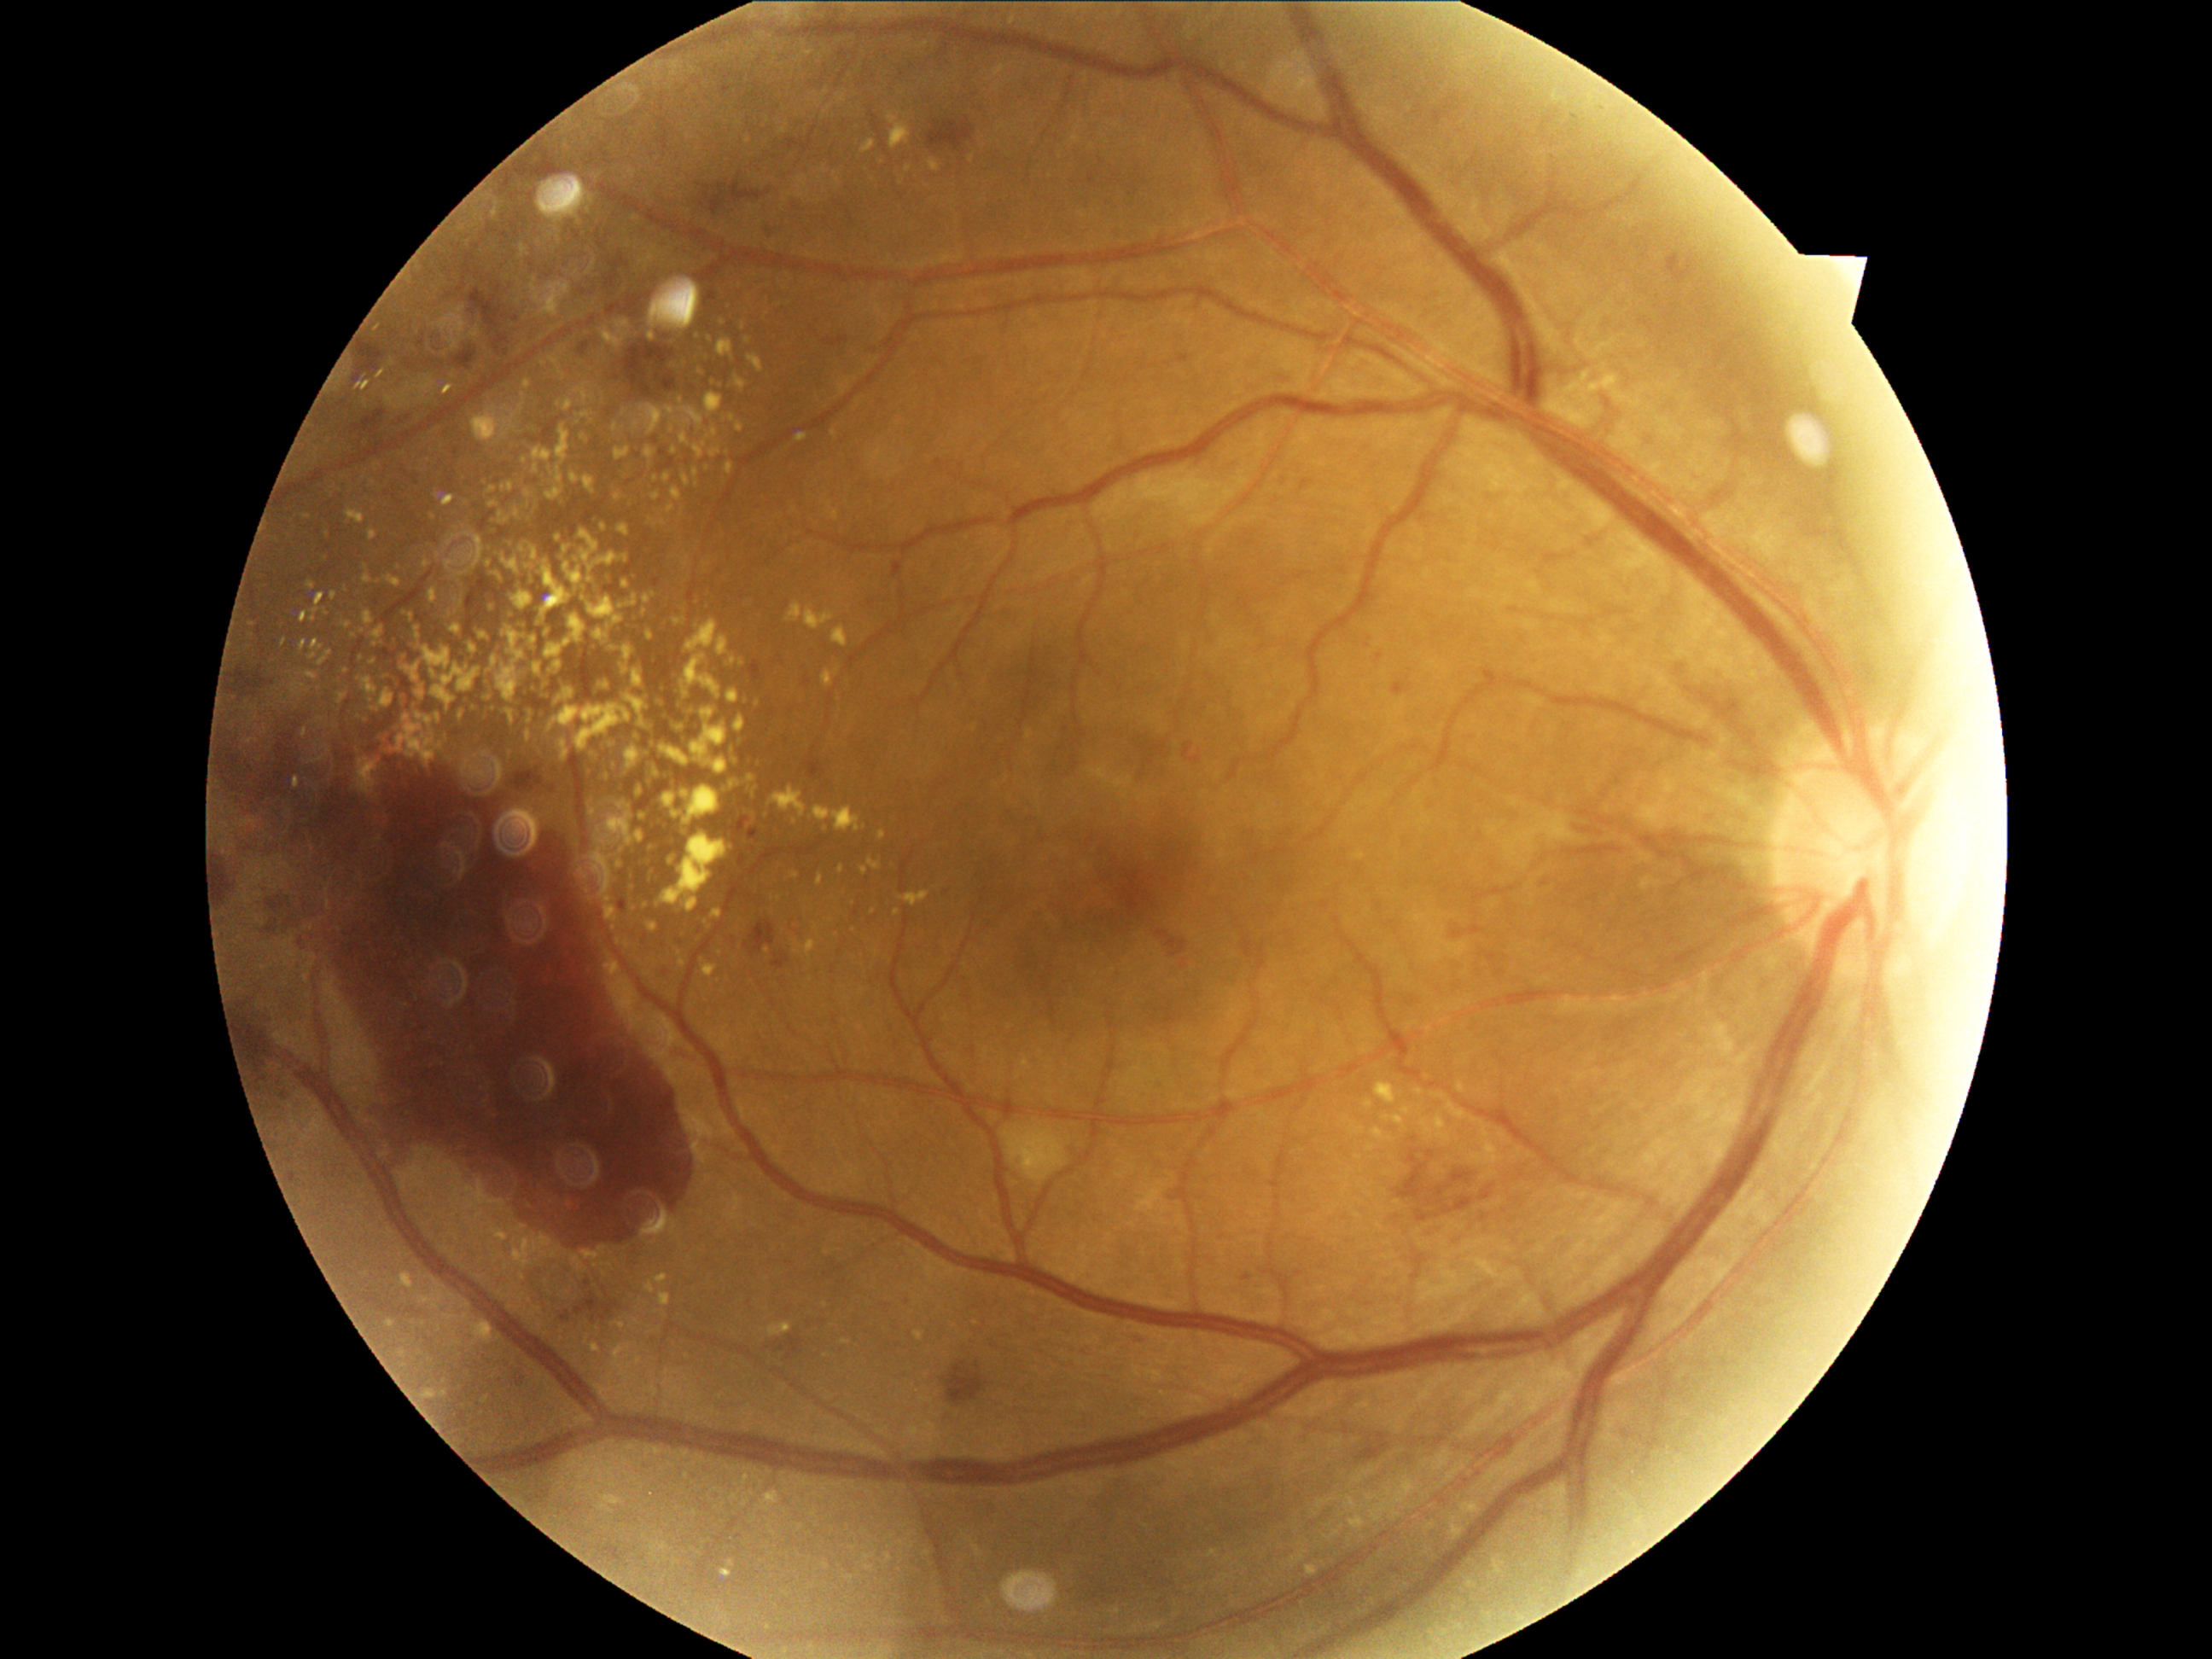 <lesions partial="true">
  <dr_grade>4</dr_grade>
  <ex partial="true">bbox=(492, 658, 498, 667) | bbox=(544, 667, 552, 678) | bbox=(359, 760, 378, 793) | bbox=(527, 711, 537, 718) | bbox=(489, 760, 503, 786) | bbox=(641, 718, 651, 731) | bbox=(339, 585, 347, 593) | bbox=(660, 1293, 672, 1307) | bbox=(496, 573, 503, 581) | bbox=(752, 699, 760, 706) | bbox=(748, 356, 762, 373) | bbox=(690, 707, 730, 776)</ex>
  <ex_small_centers>(396,728) | (671,508) | (529,566) | (1420,1092) | (506,432) | (347,671) | (560,557)</ex_small_centers>
</lesions>